Fundus photo. FOV: 45 degrees. 2352x1568.
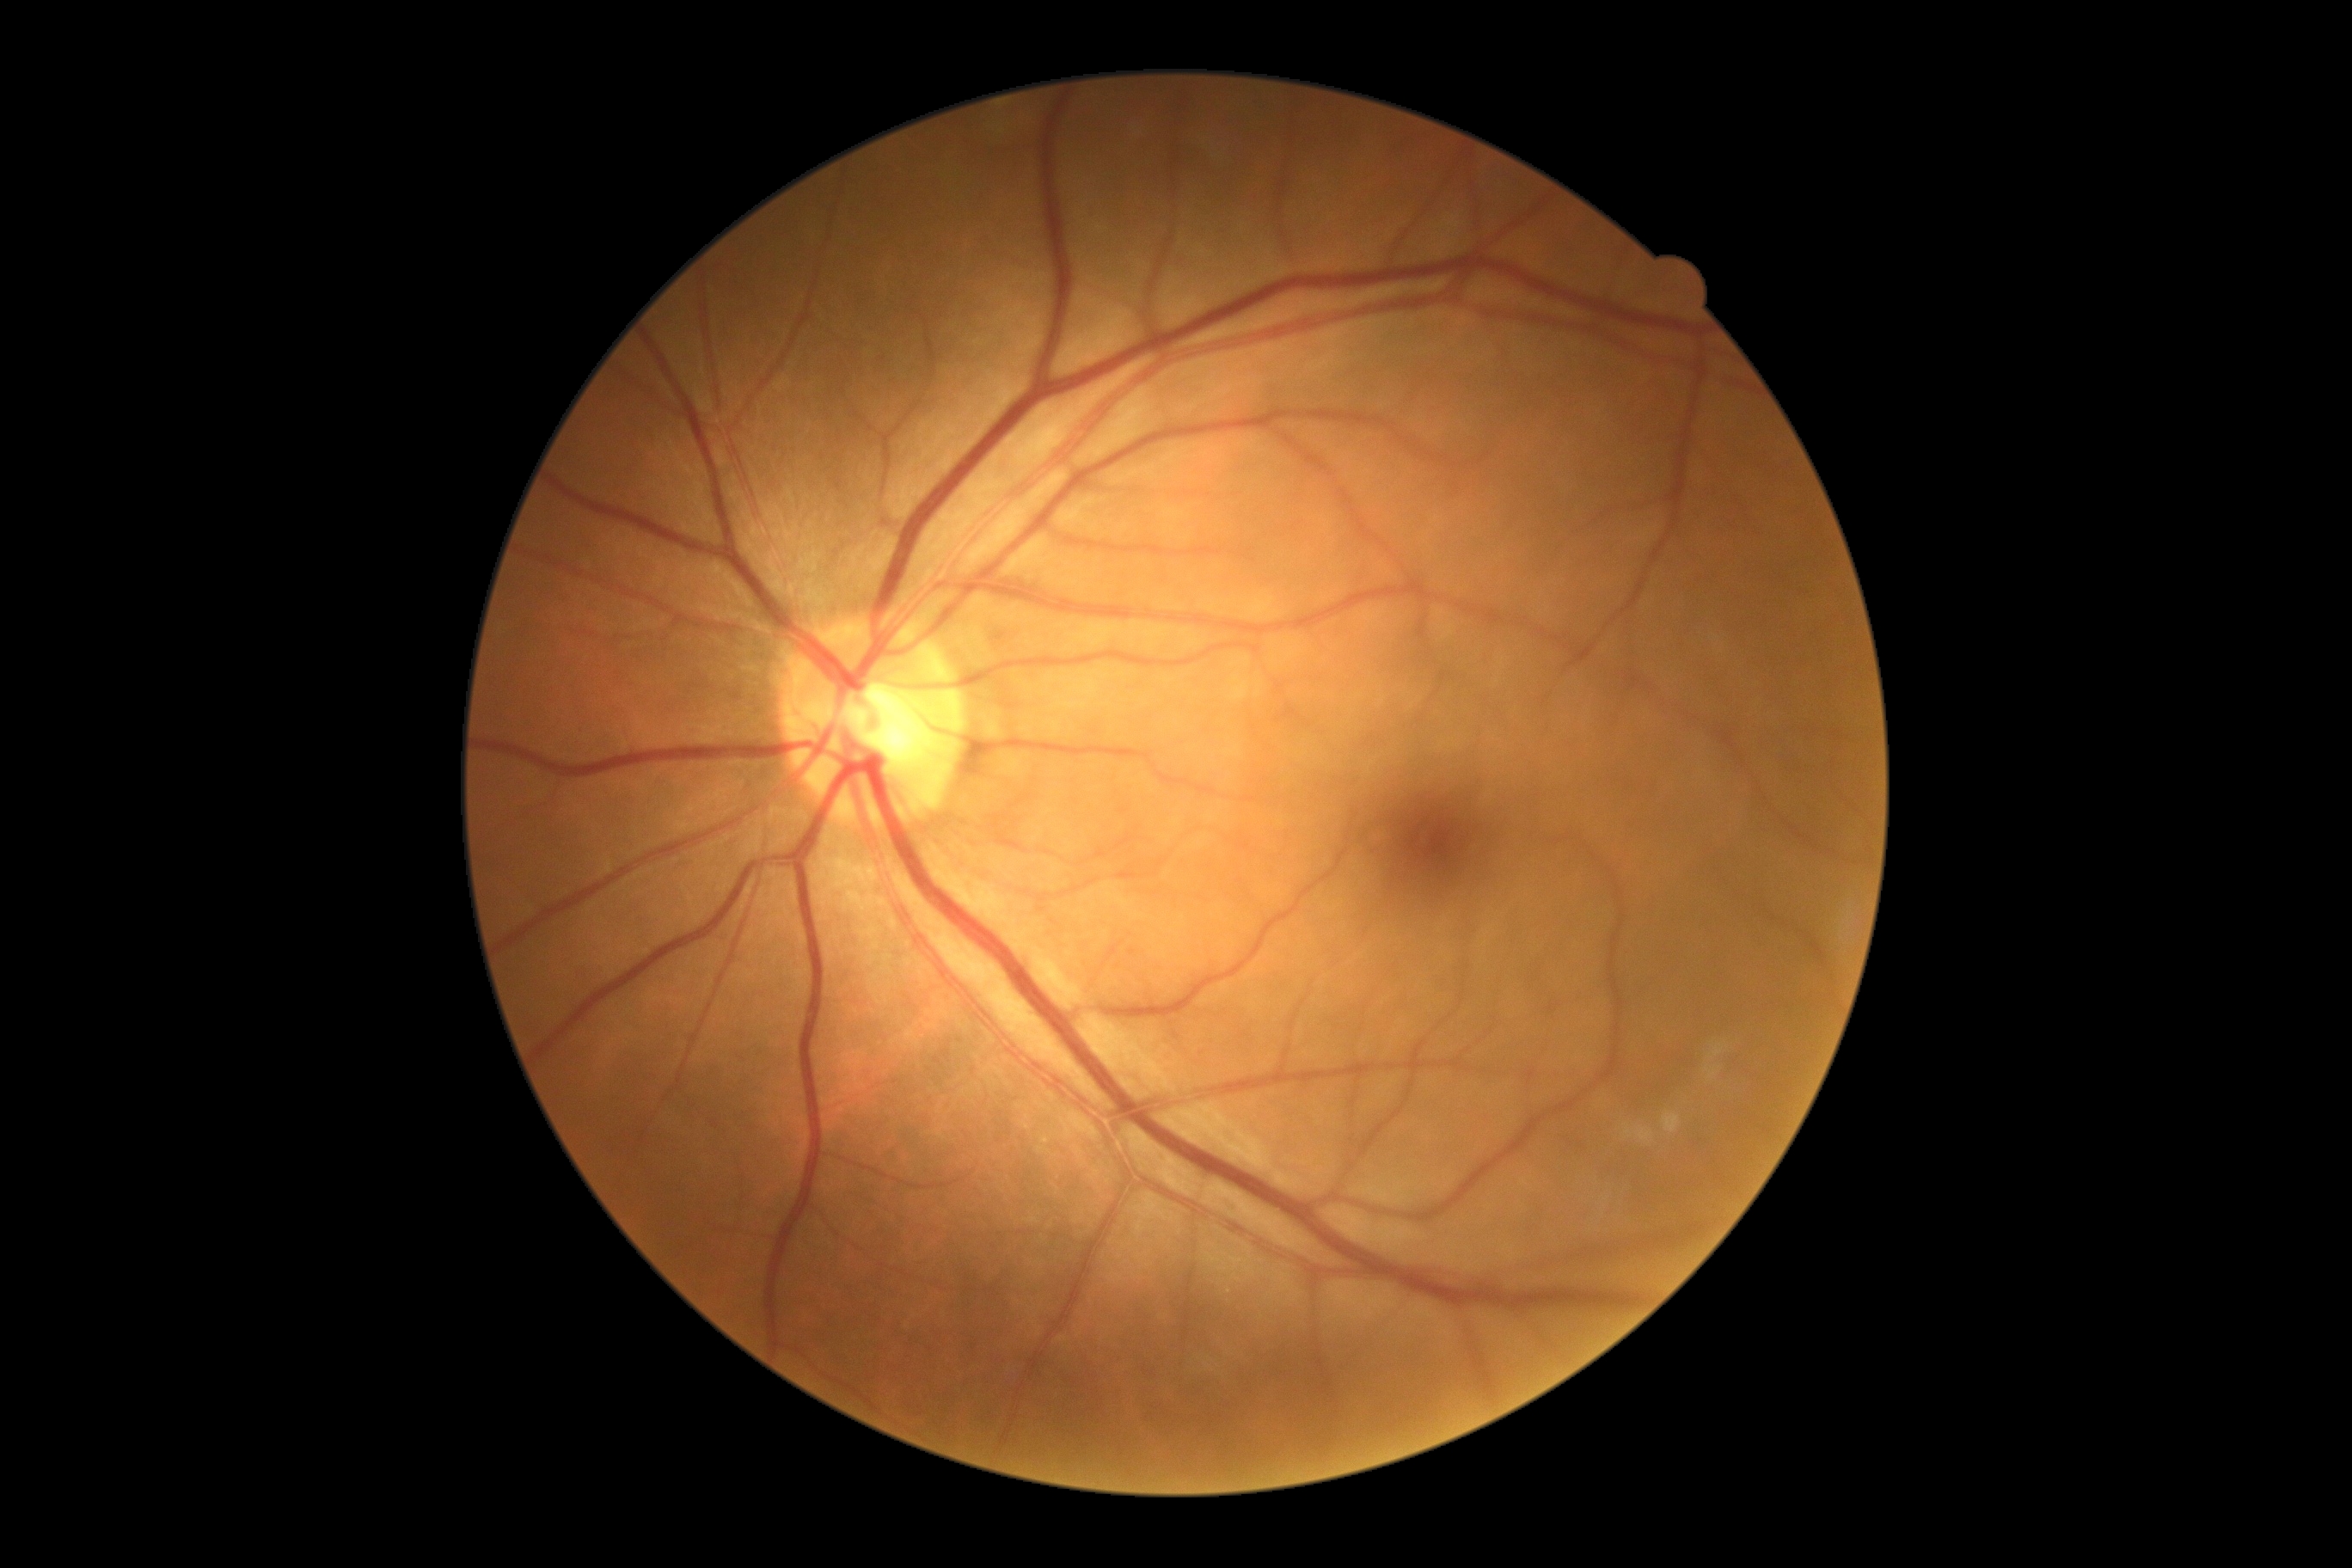
diabetic retinopathy grade@0/4.